Retinal fundus photograph.
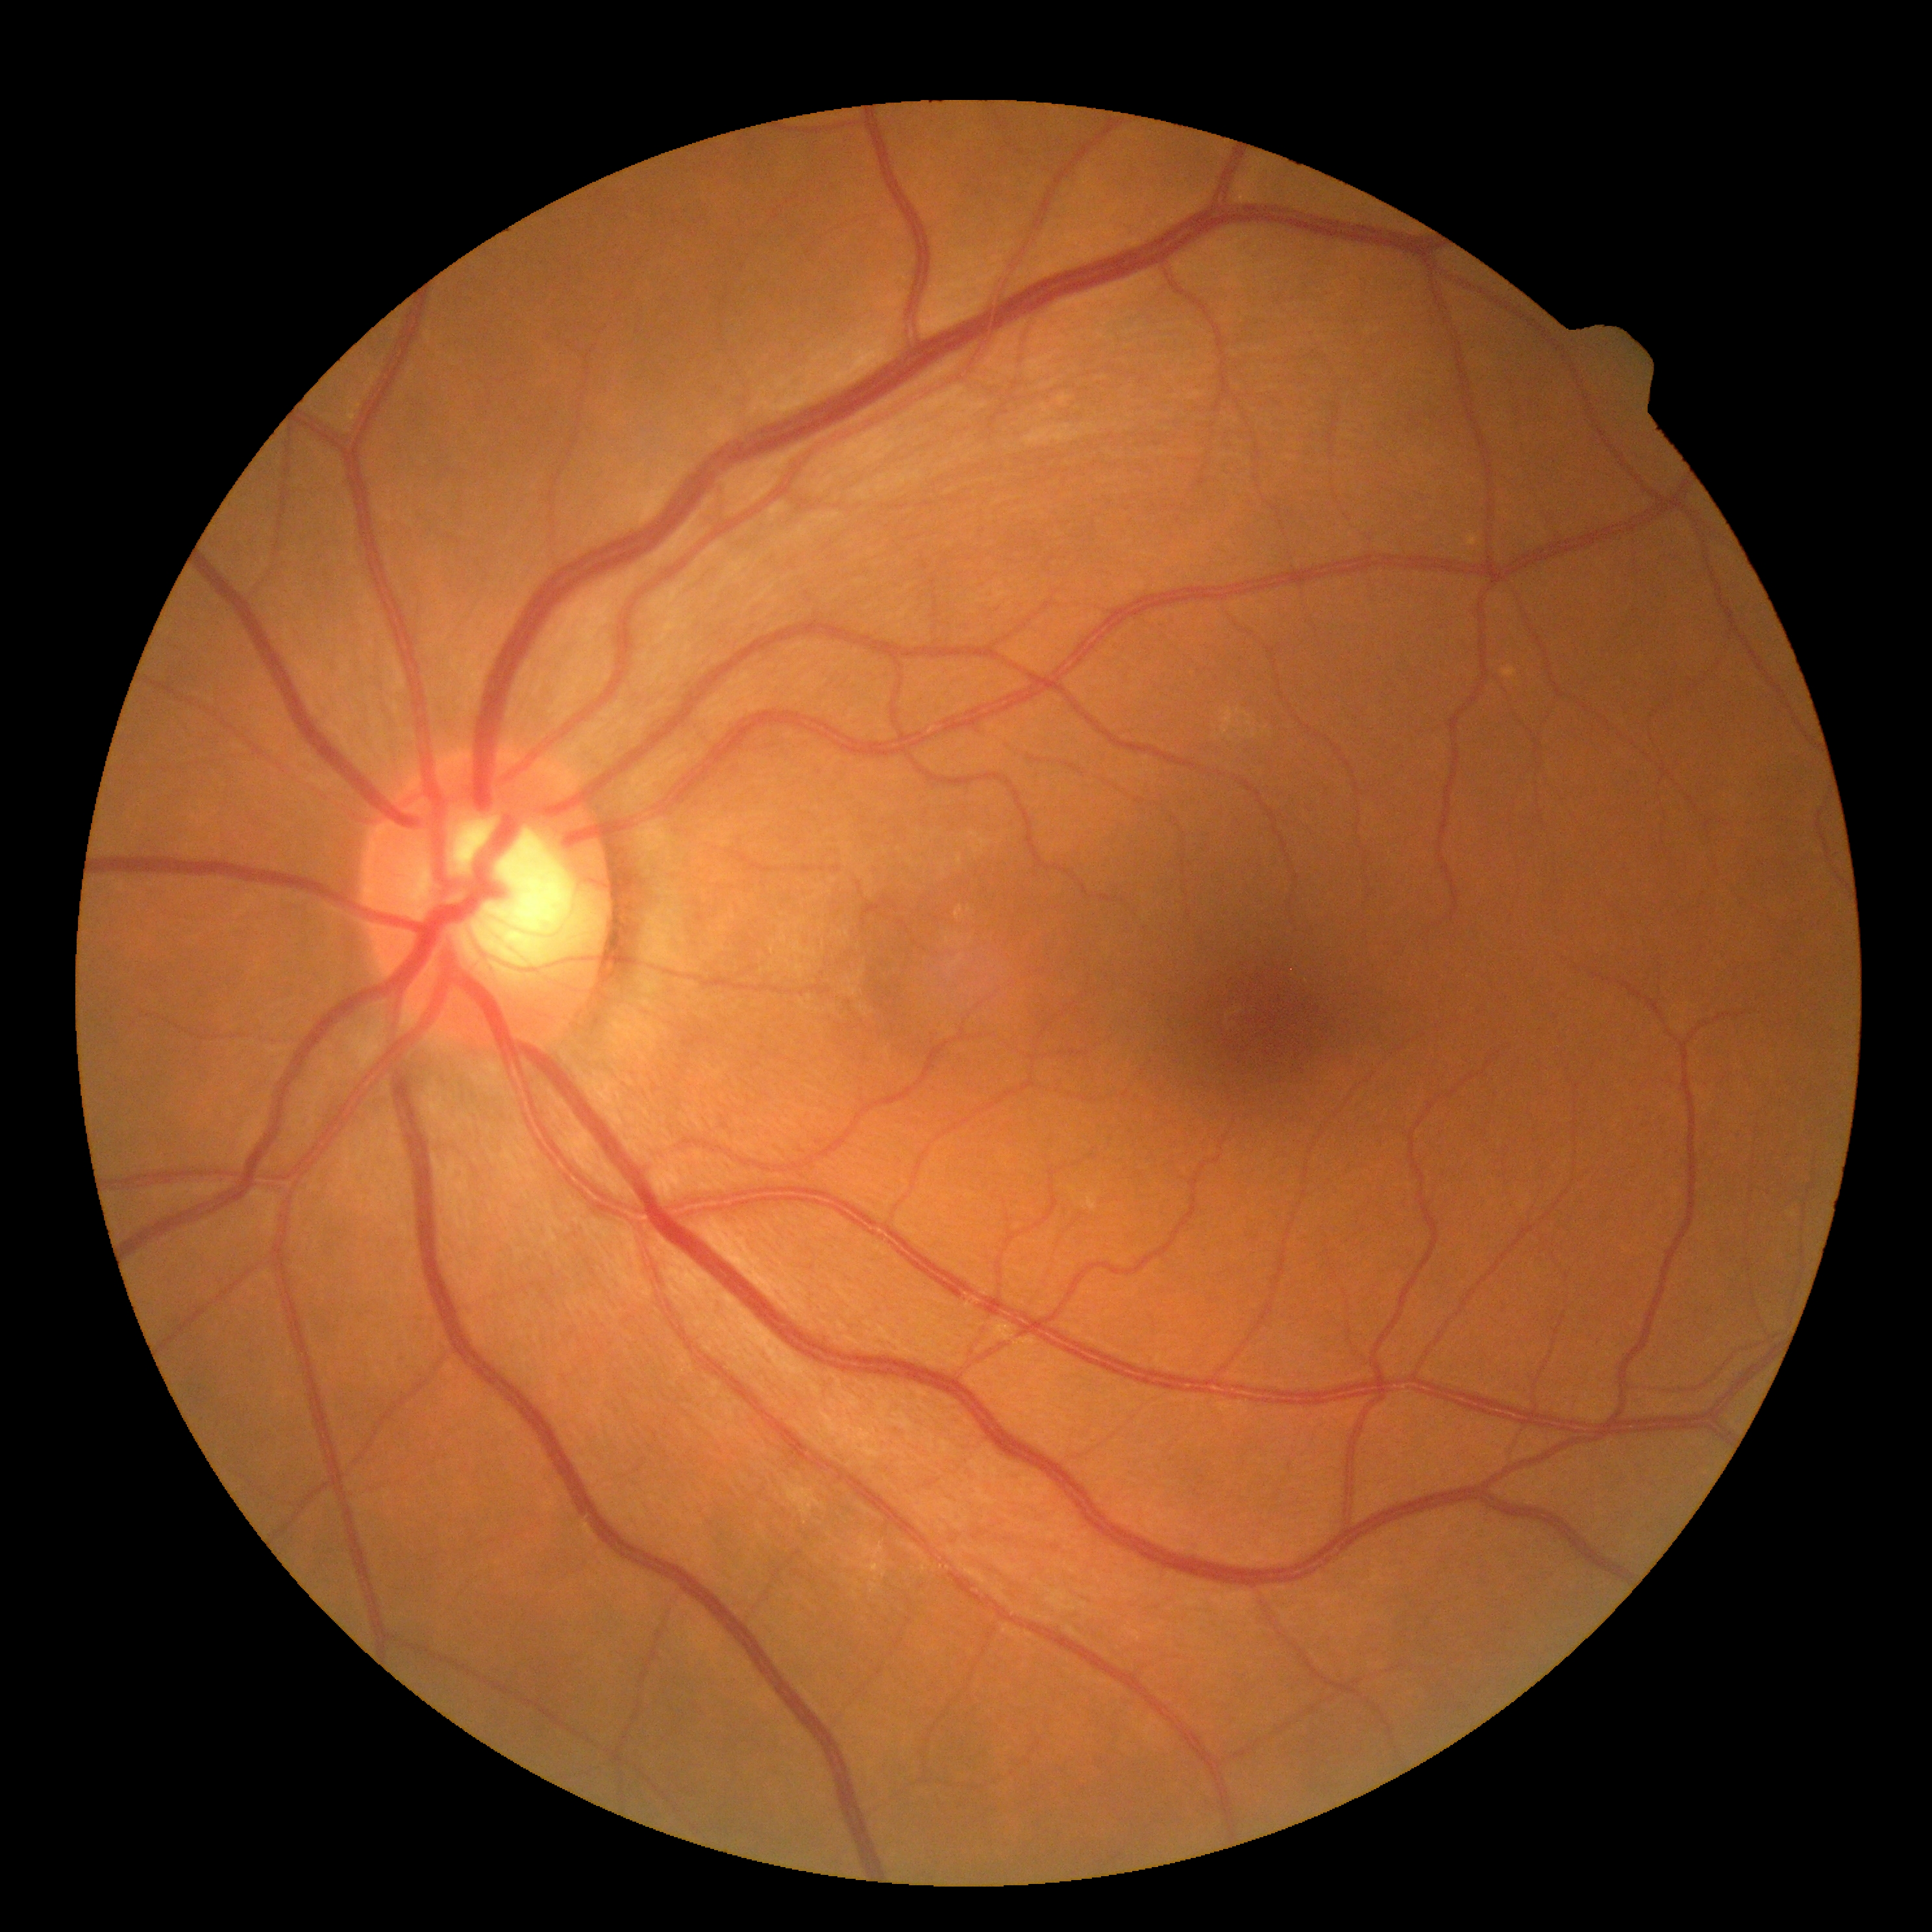 • DR grade: 0 (no apparent retinopathy) — no visible signs of diabetic retinopathy